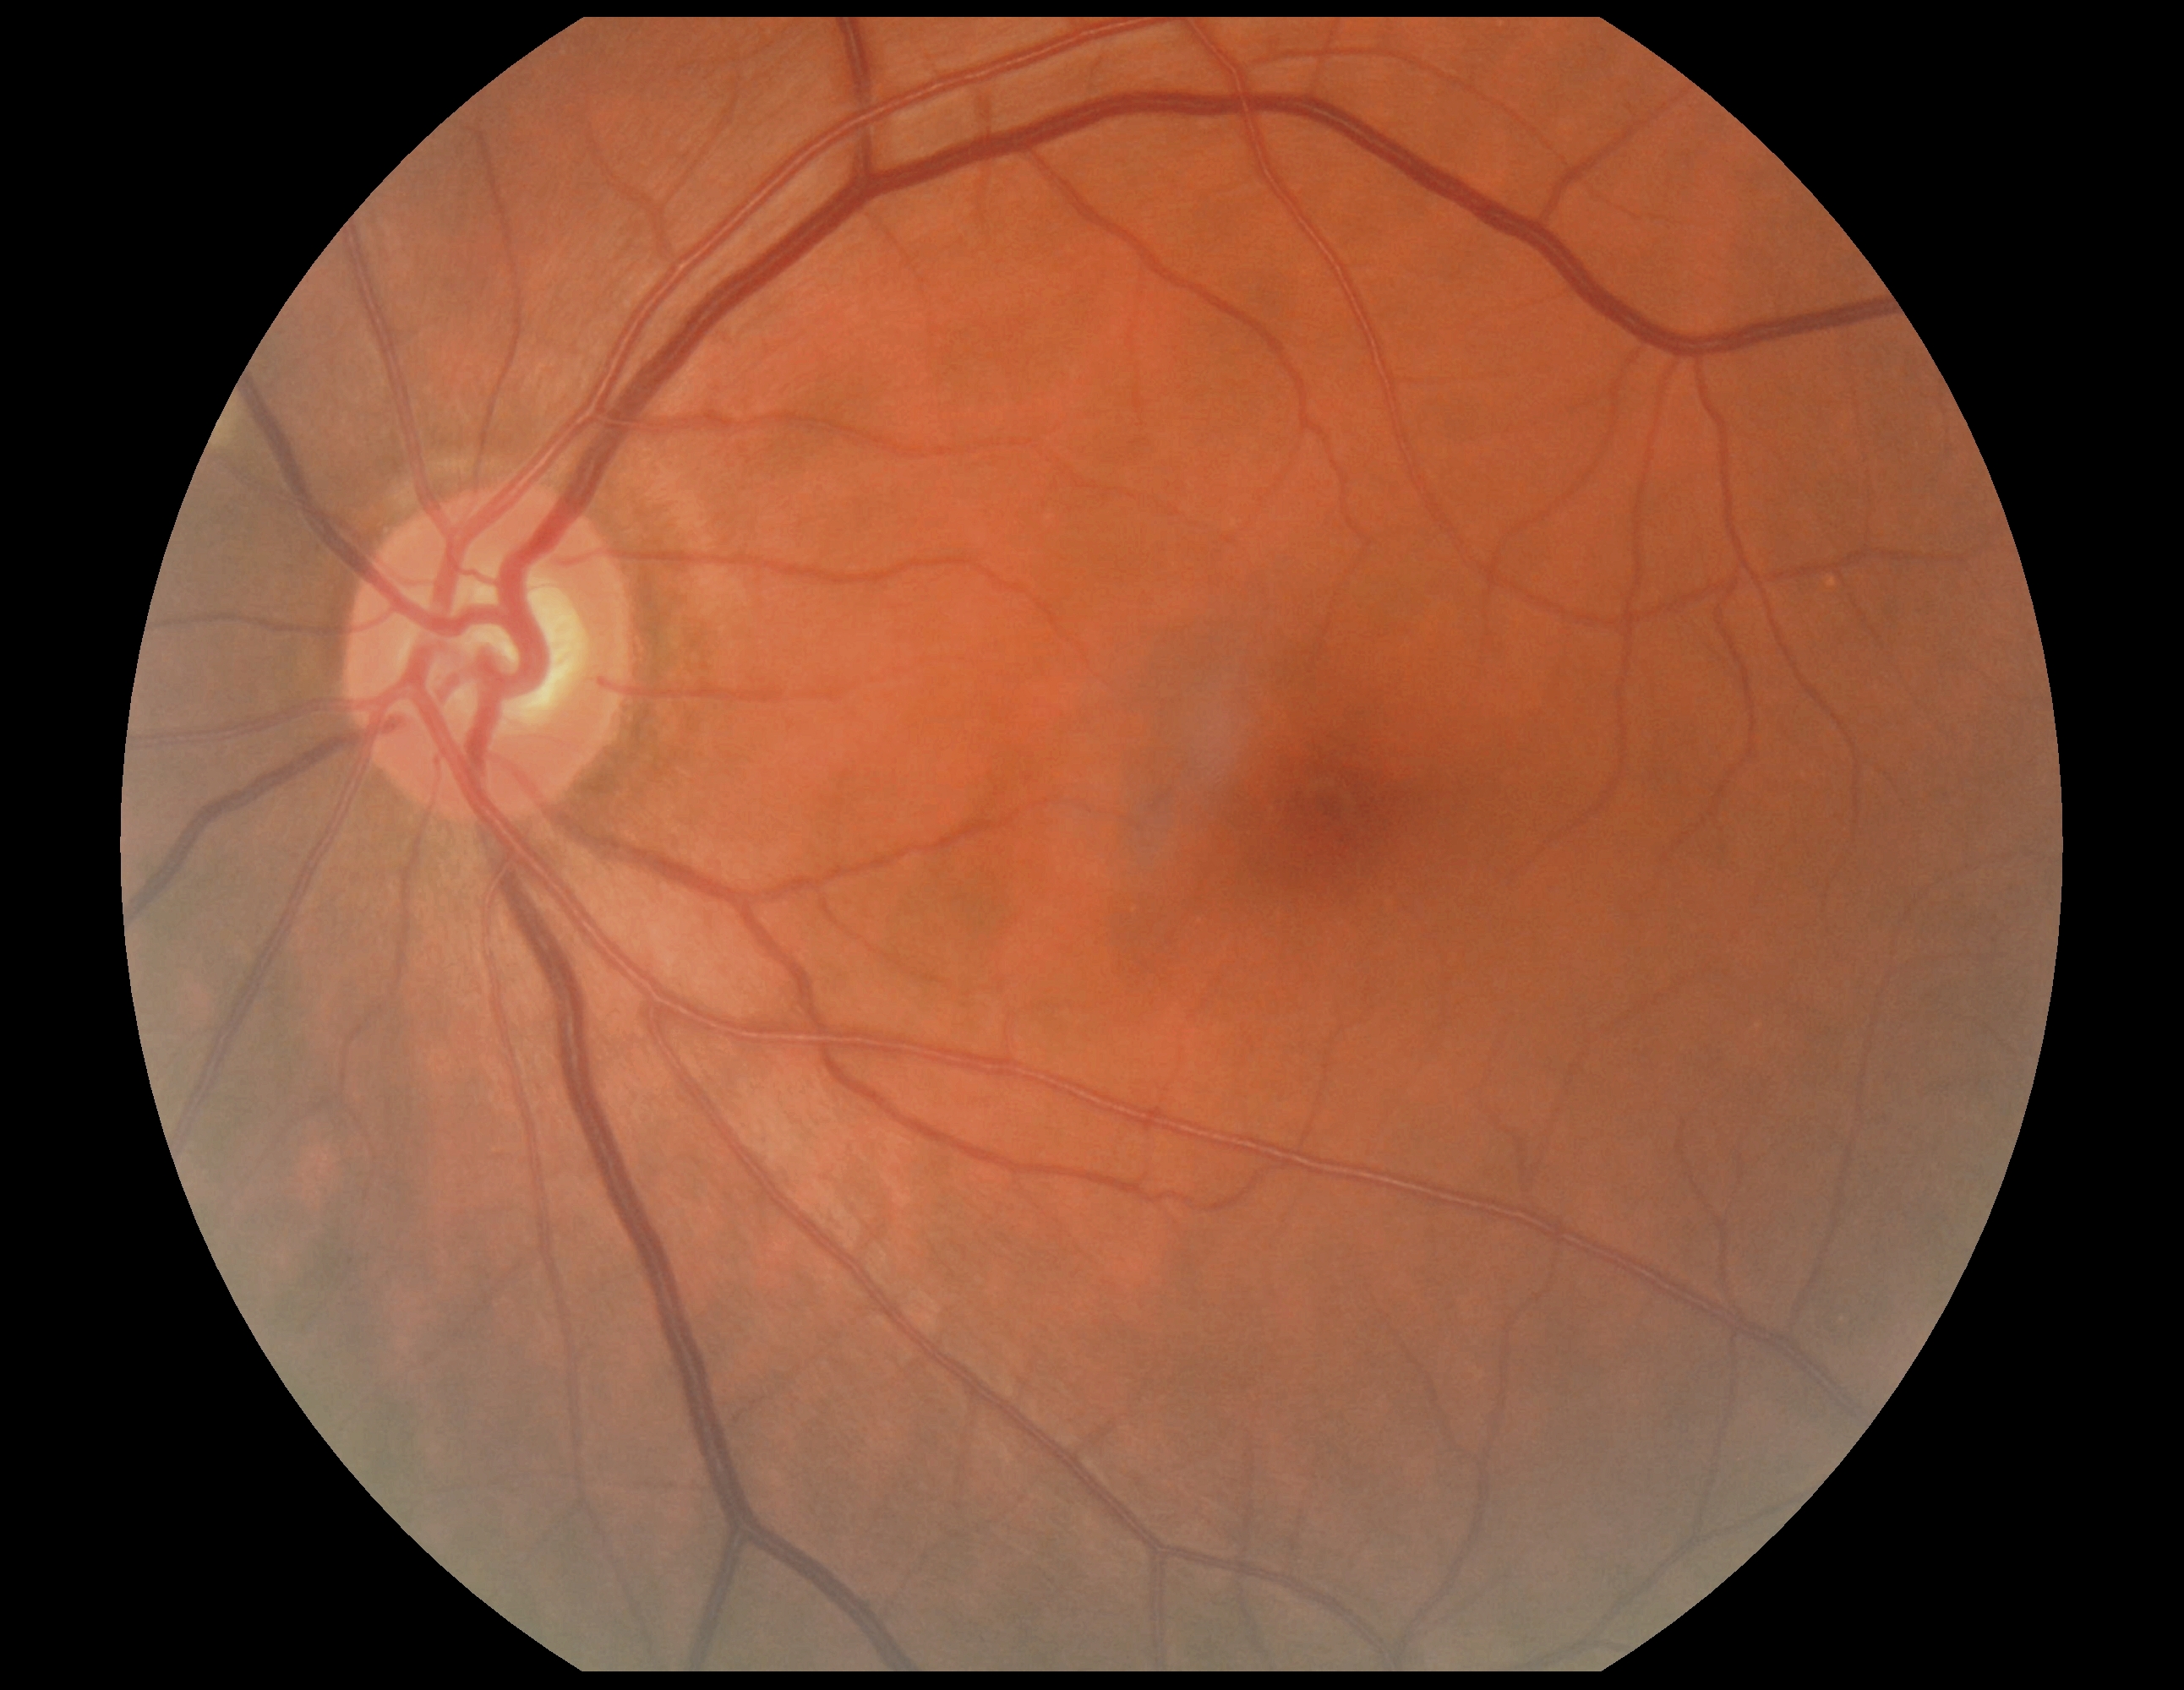 Annotations:
• DR: no apparent diabetic retinopathy (grade 0)